Camera: NIDEK AFC-230.
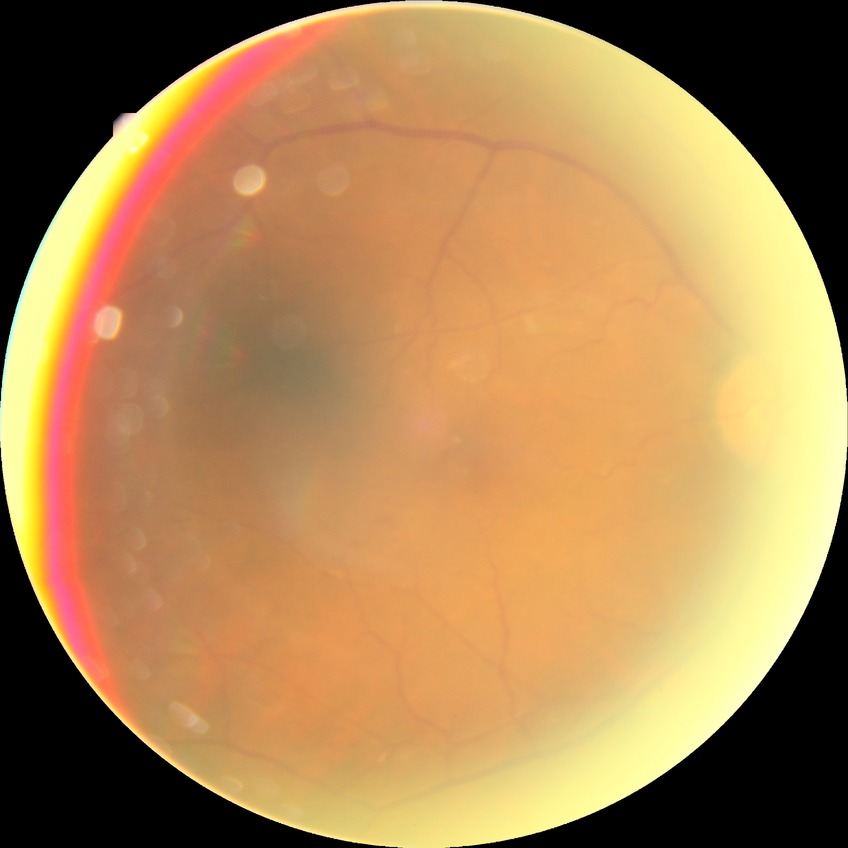 Diabetic retinopathy (DR): simple diabetic retinopathy (SDR).